Infant wide-field fundus photograph. 640 by 480 pixels:
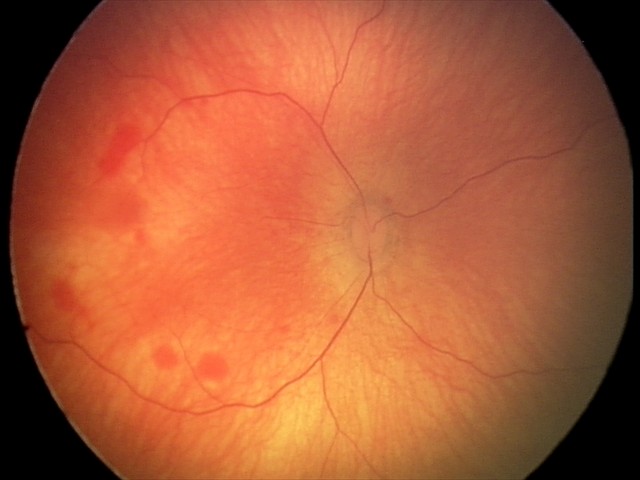 Impression: retinal hemorrhages.